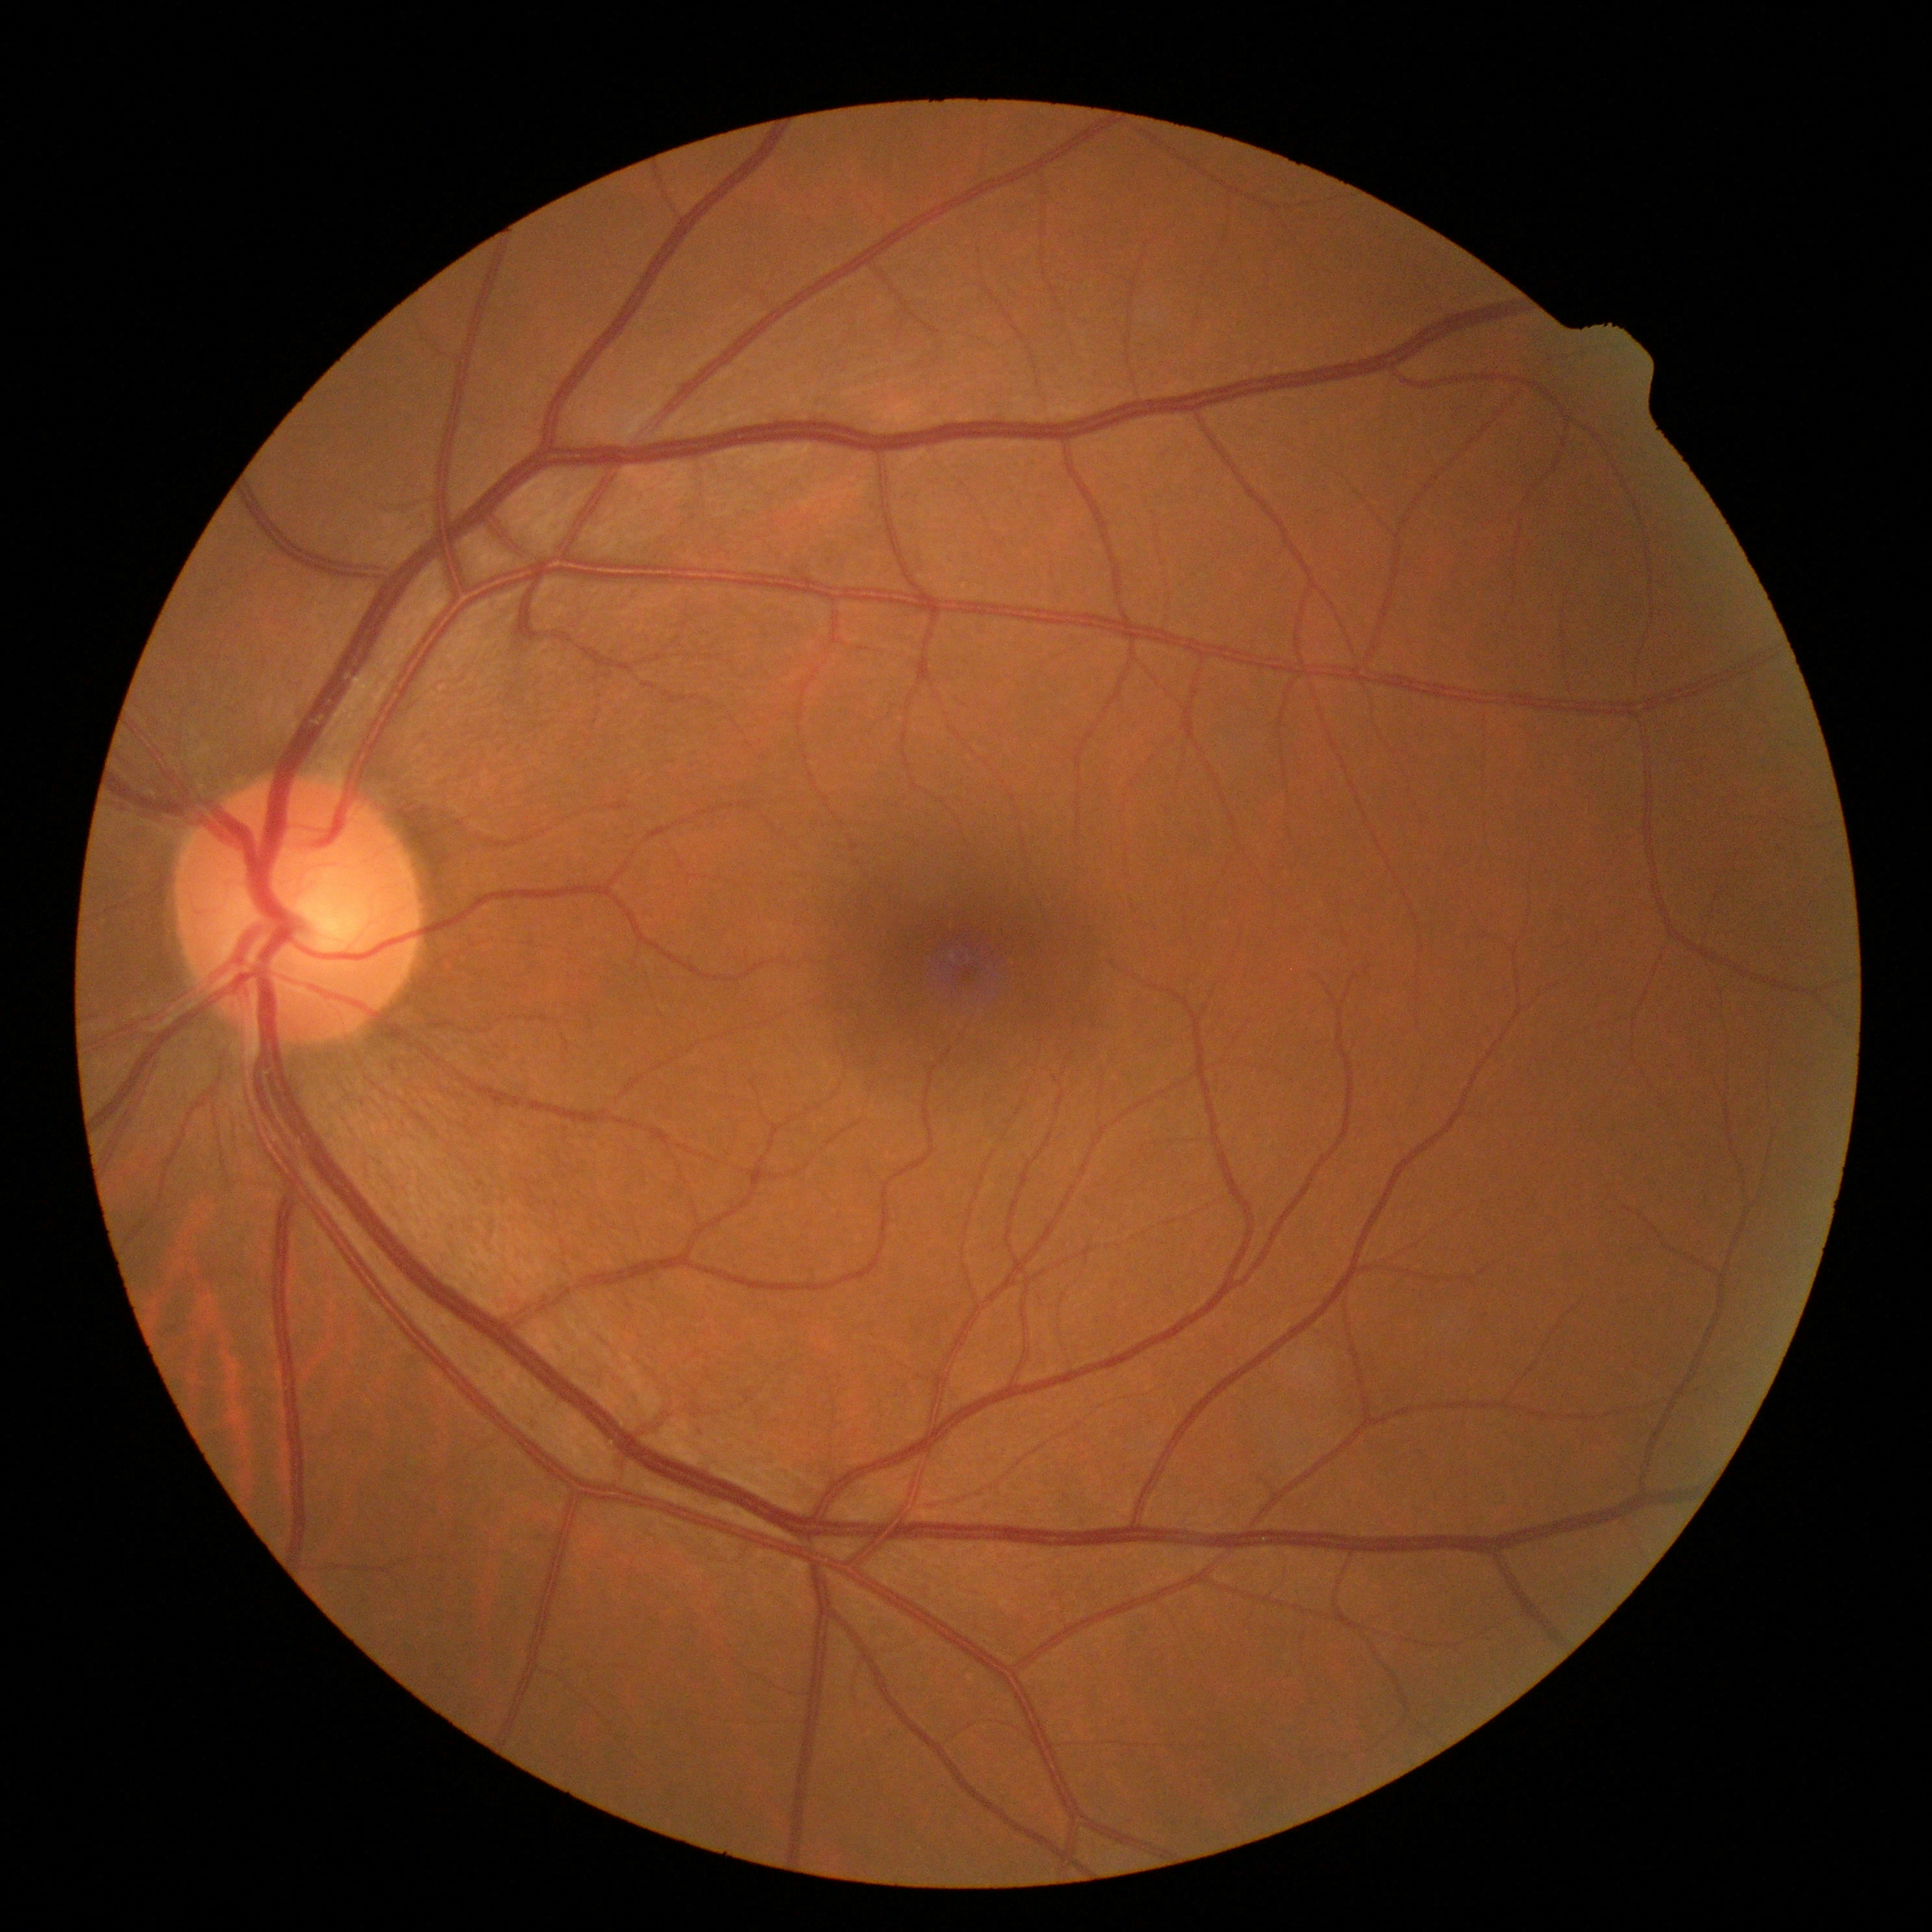
DR: grade 0 (no apparent retinopathy), DR impression: no DR findings.